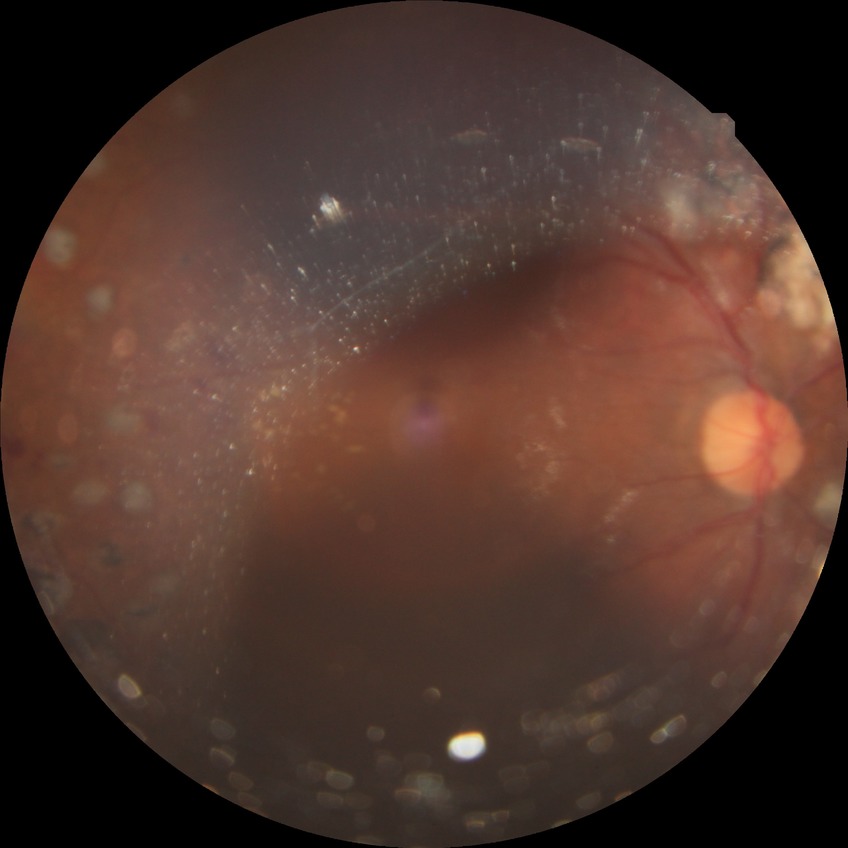

Diabetic retinopathy (DR) is proliferative diabetic retinopathy (PDR).